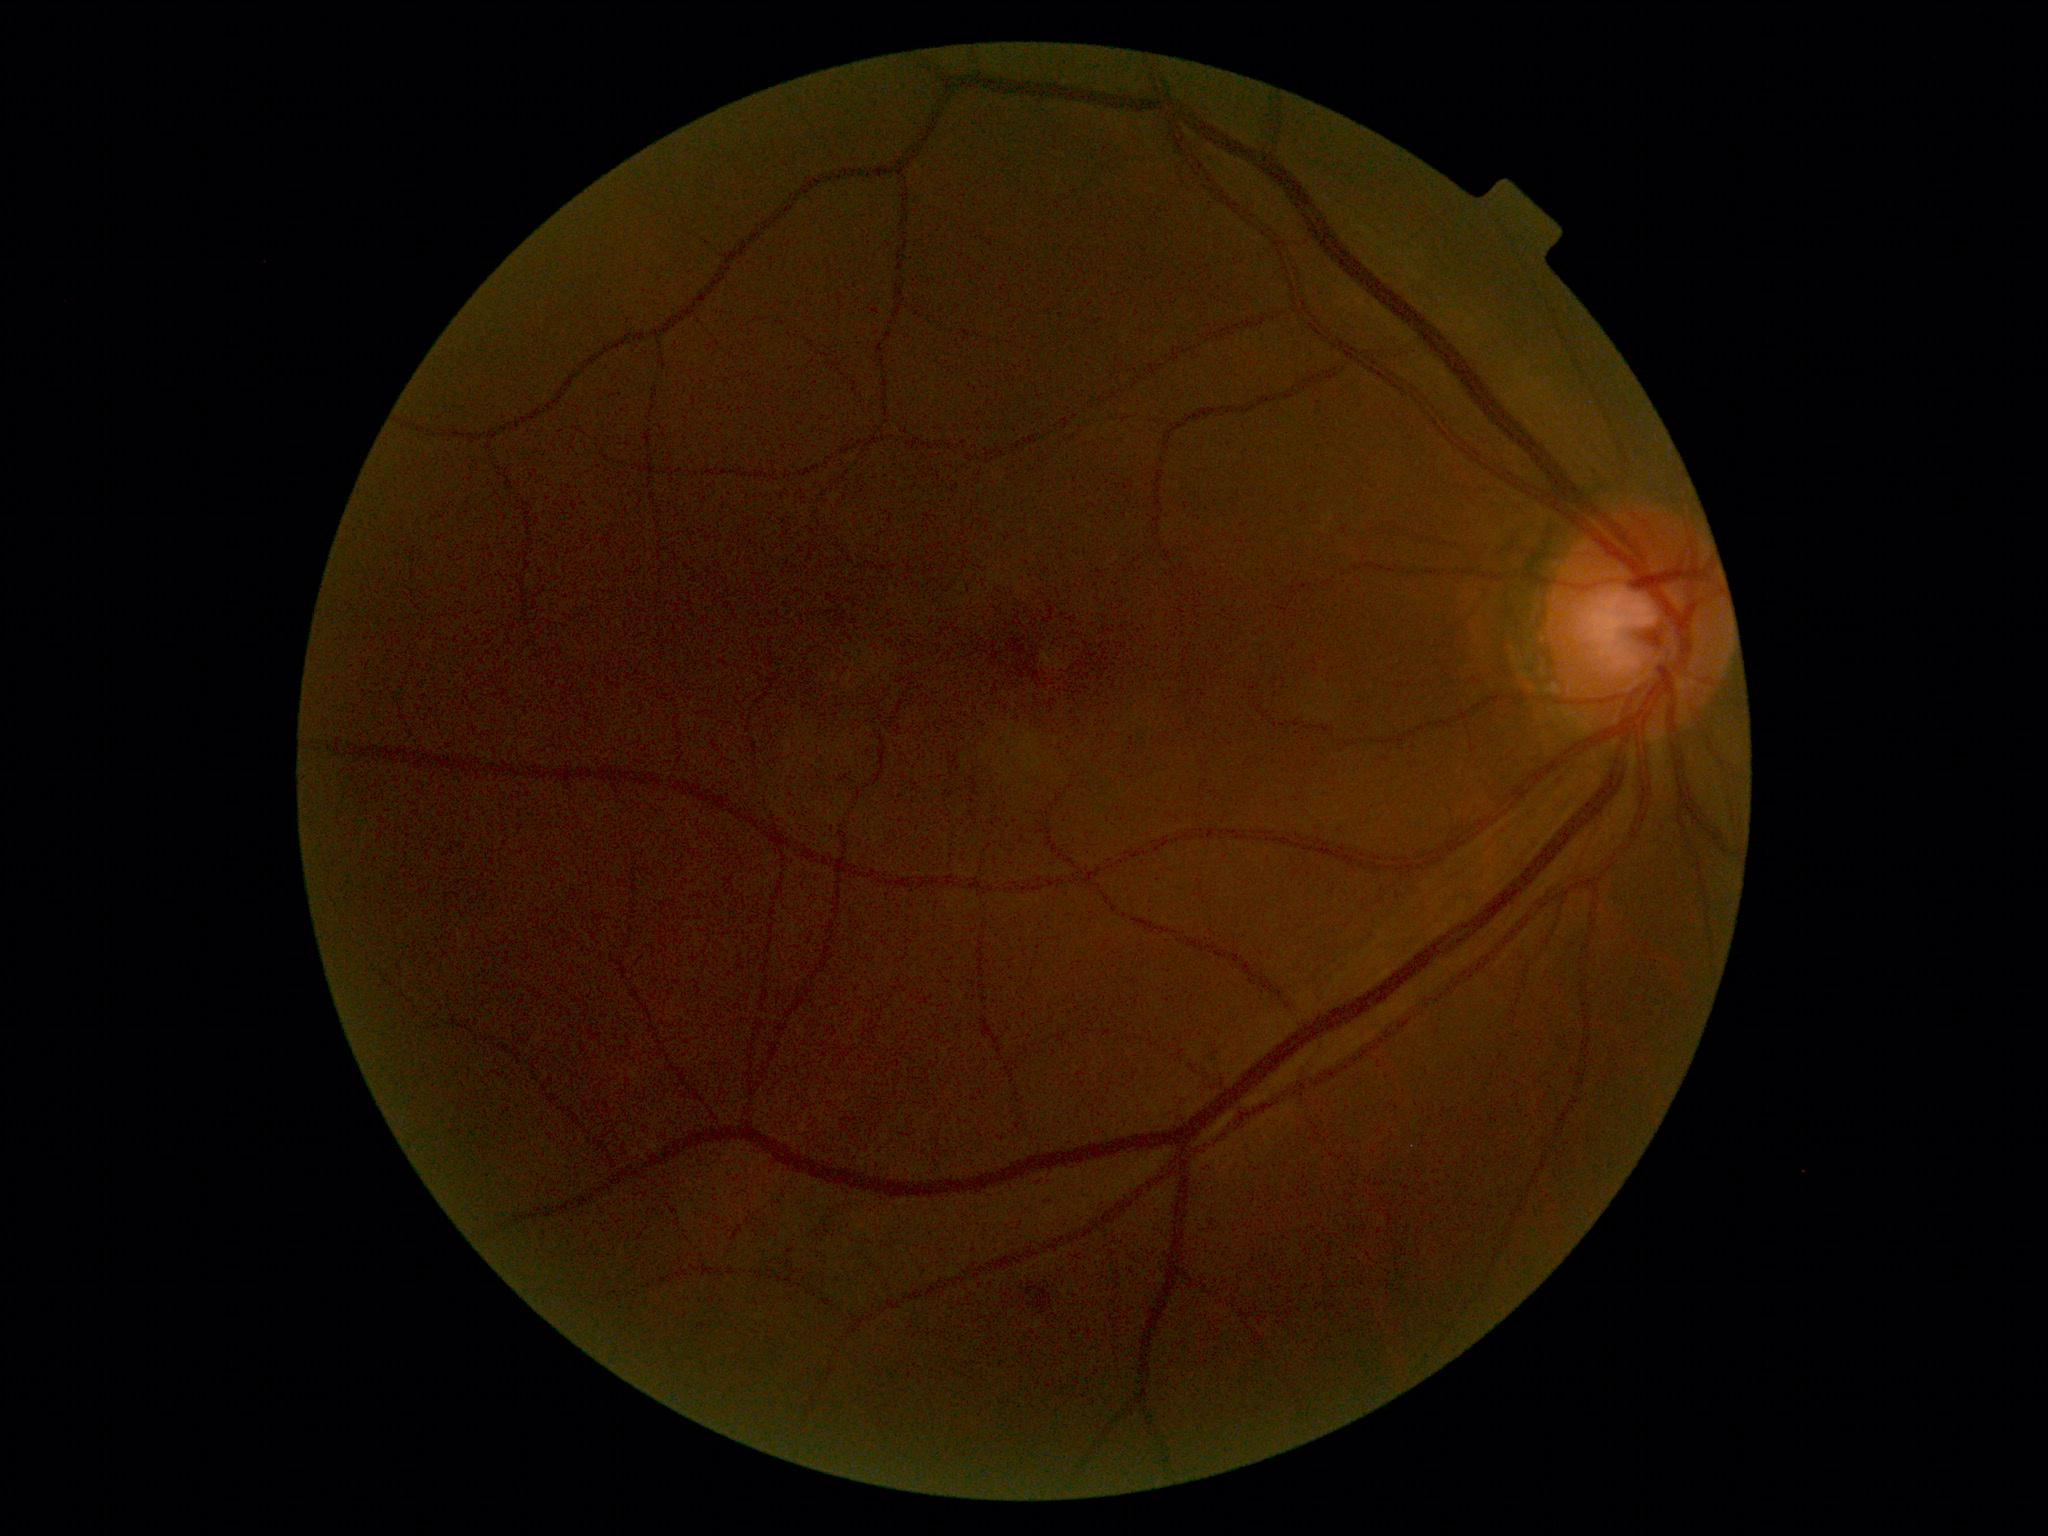 diabetic retinopathy = moderate NPDR (grade 2)